Fundus photo — 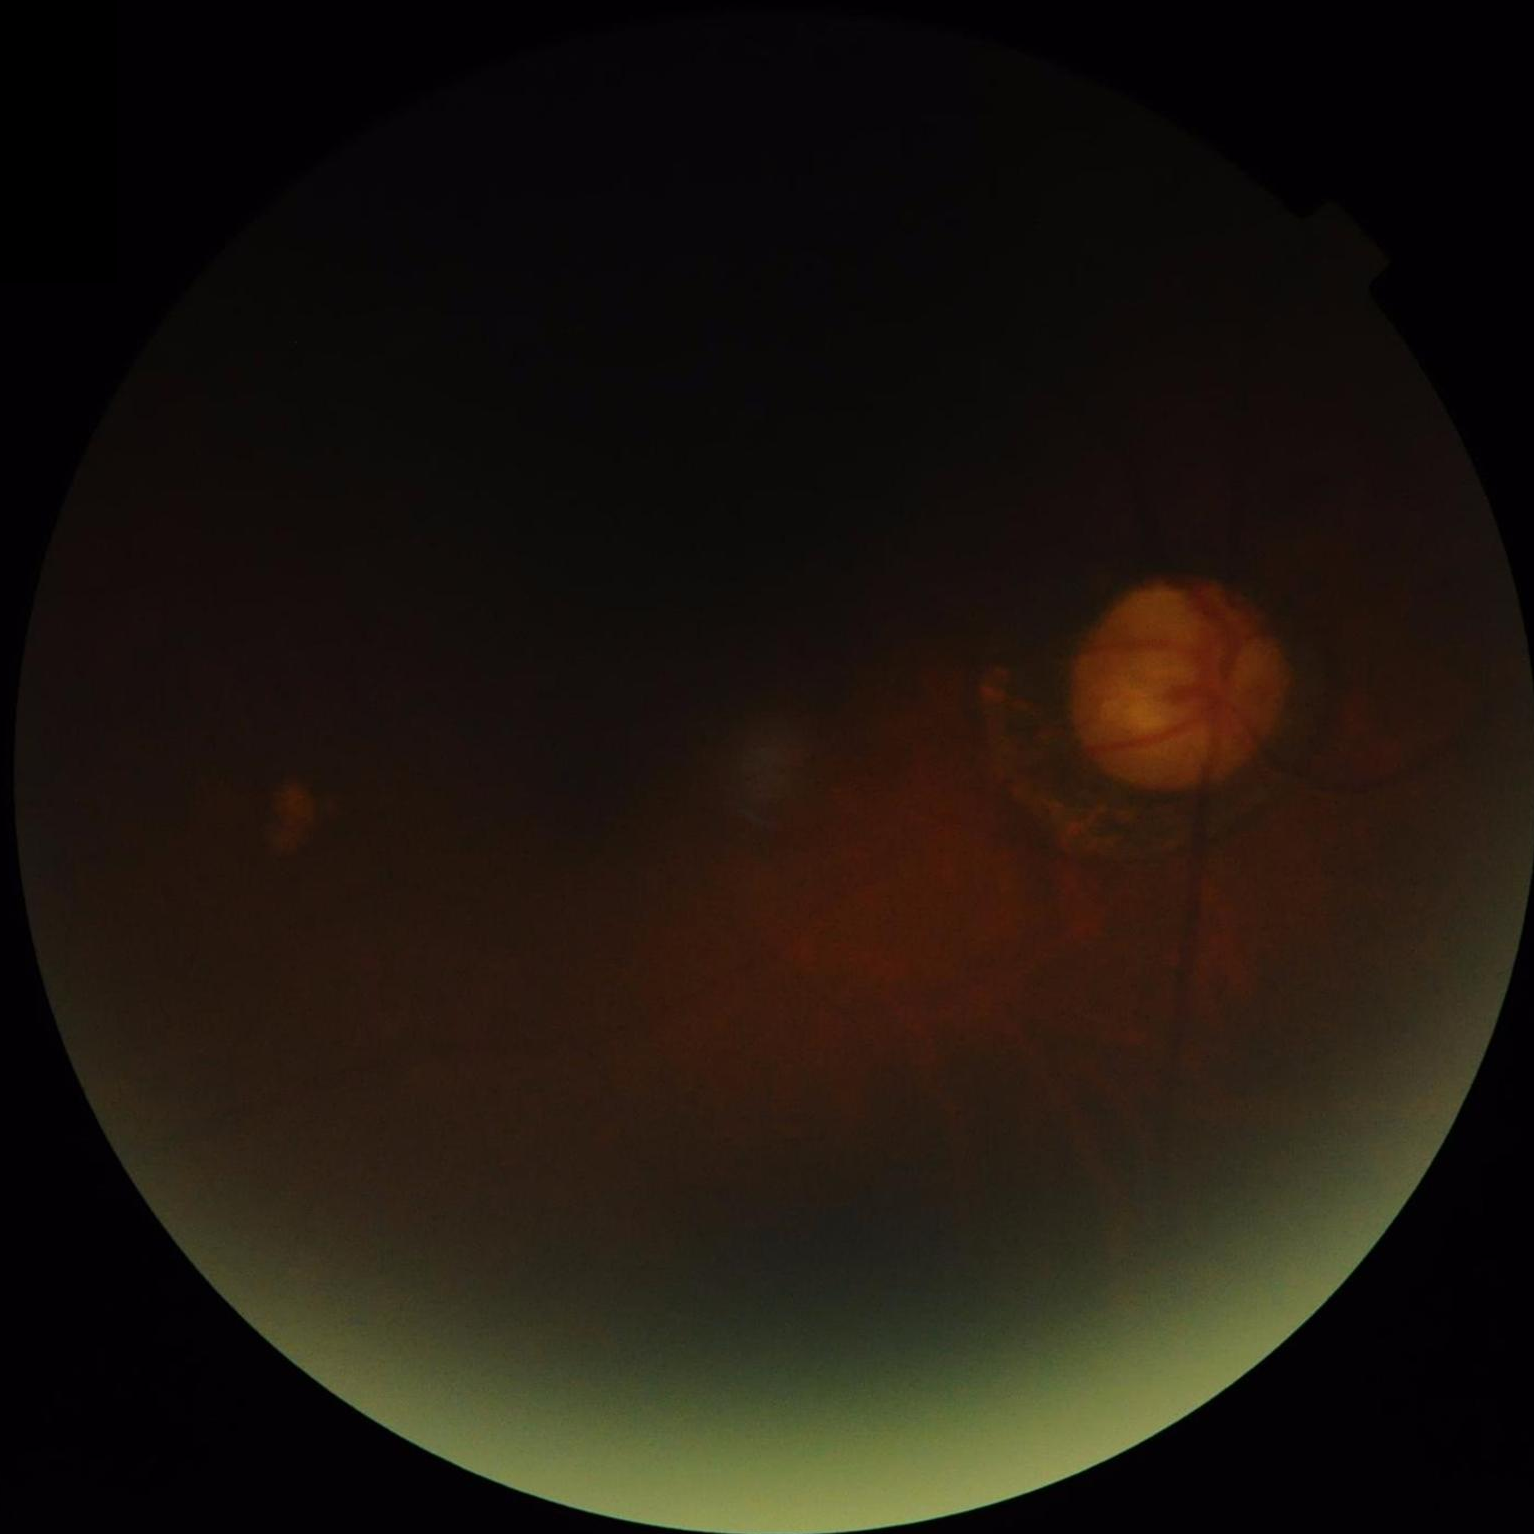 Image quality is inadequate for diagnostic use.
Poor illumination with uneven exposure.
Contrast is low.
Reduced sharpness with visible blur.